Modified Davis grading
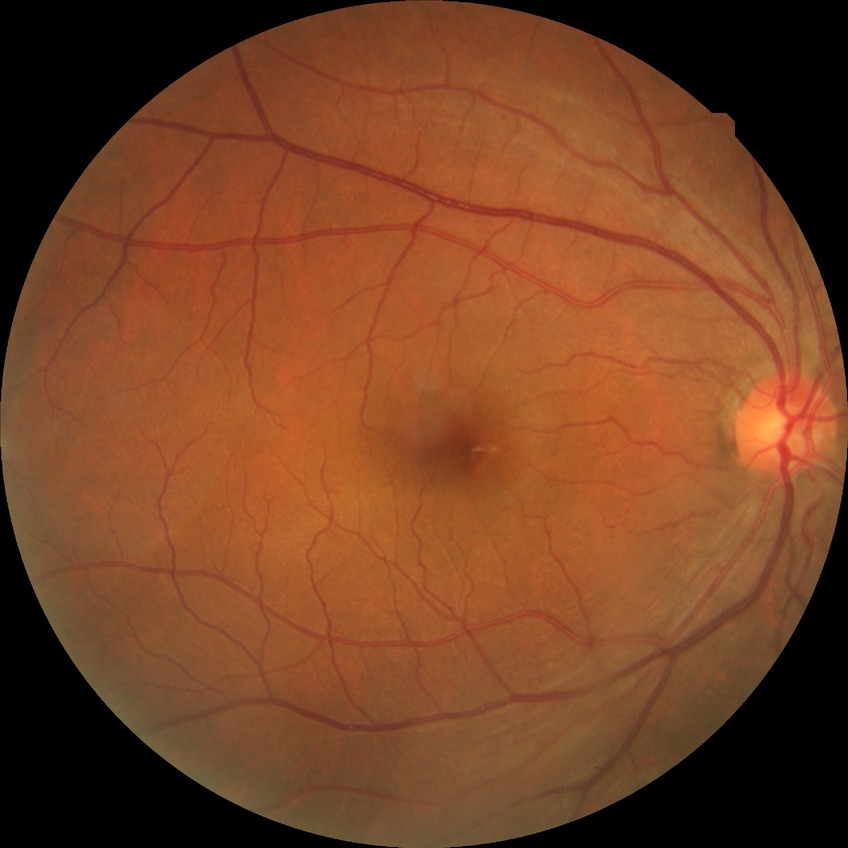 Modified Davis classification is no diabetic retinopathy.